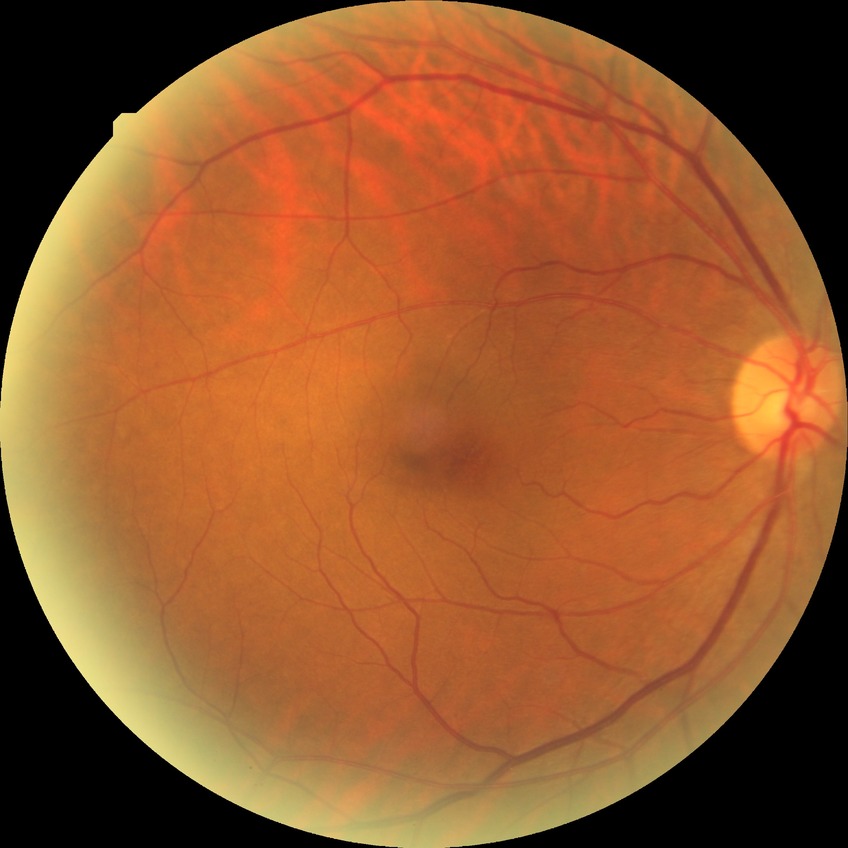 Davis stage: NDR.